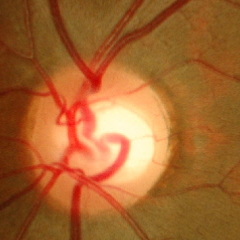 Findings consistent with no signs of glaucoma.